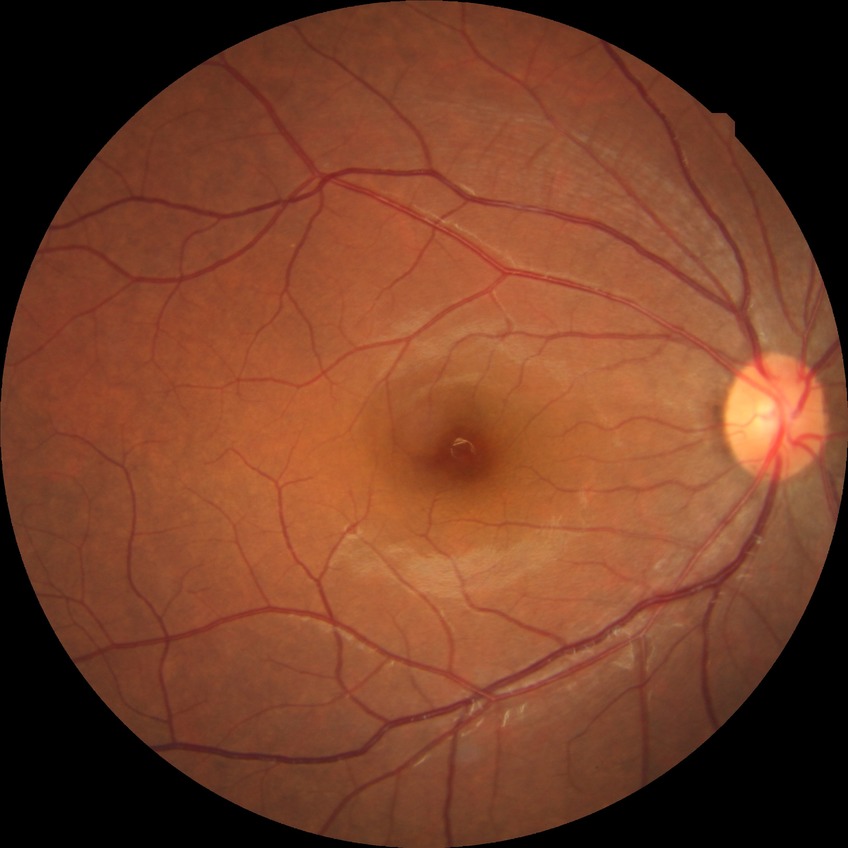
Diabetic retinopathy (DR): NDR (no diabetic retinopathy).